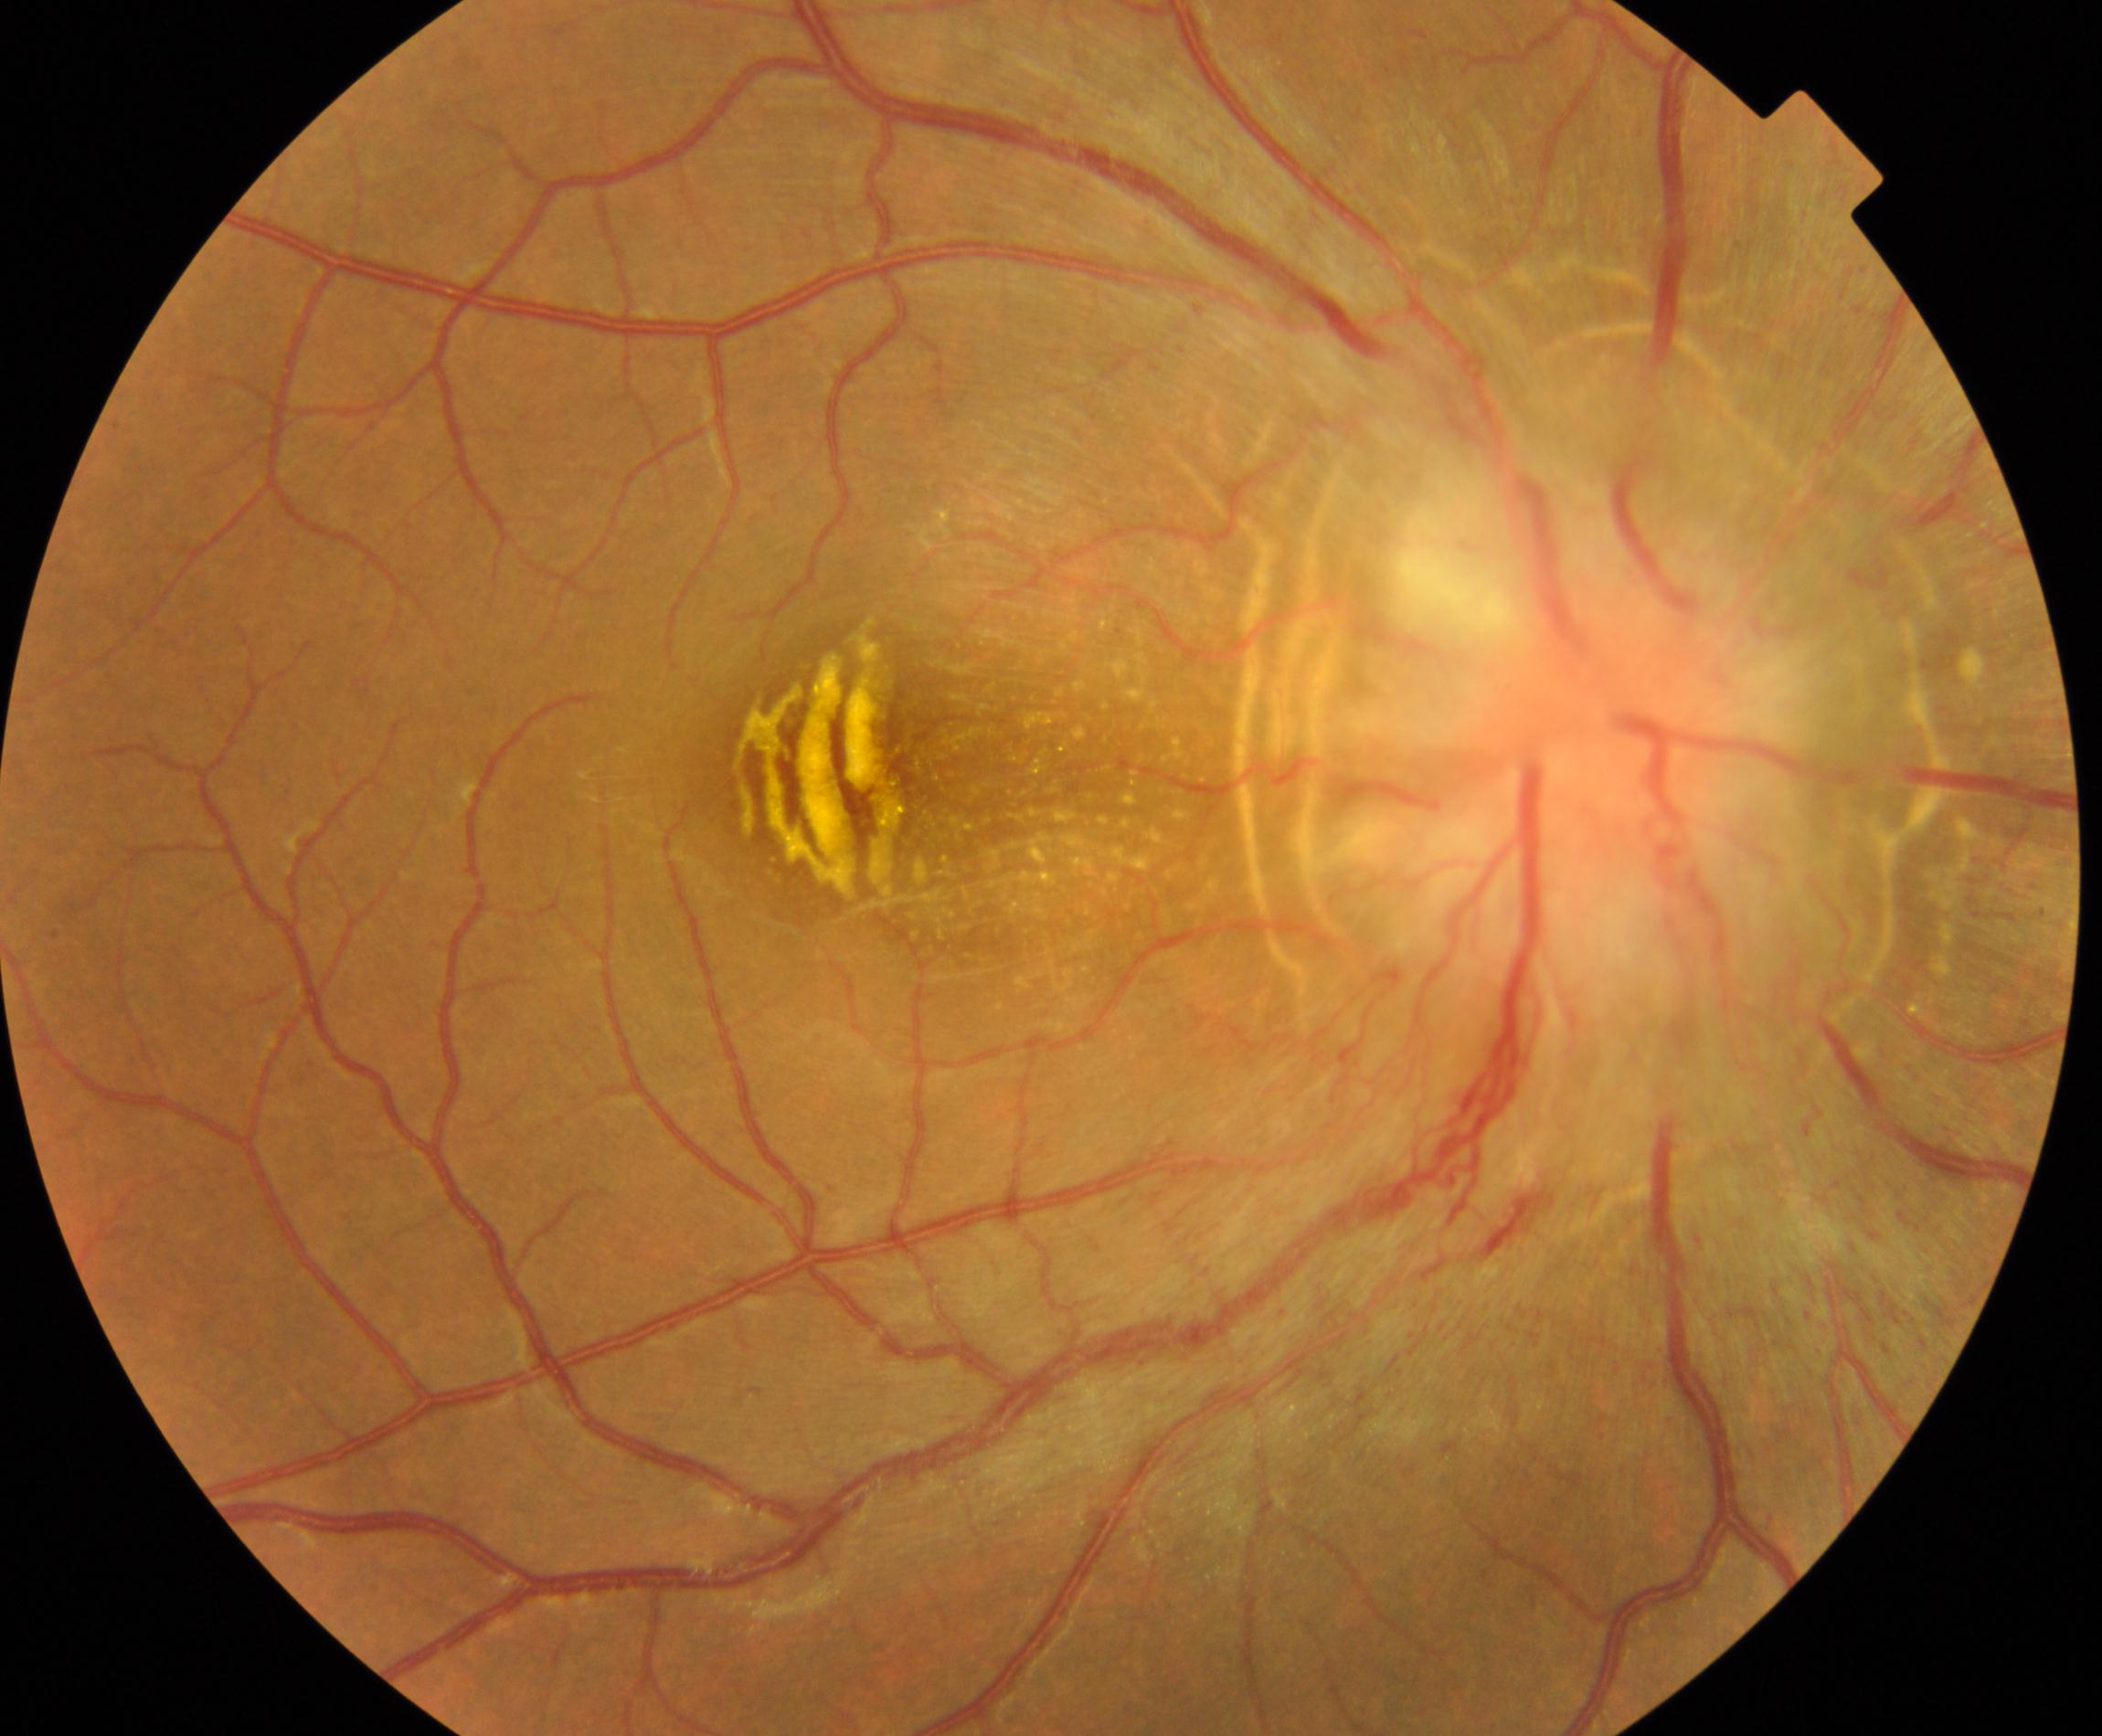

Retinal fundus photograph demonstrating disc swelling and elevation. Typically showing disc hyperemia and elevation with indistinct disc margins, sometimes with peripapillary flame hemorrhages and cotton-wool spots.